Pediatric wide-field fundus photograph: 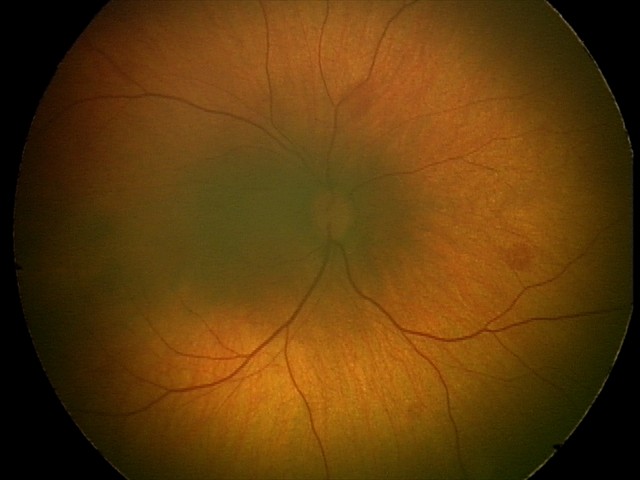

Diagnosis from this screening exam: retinal hemorrhages.